2352 x 1568 pixels. Retinal fundus photograph
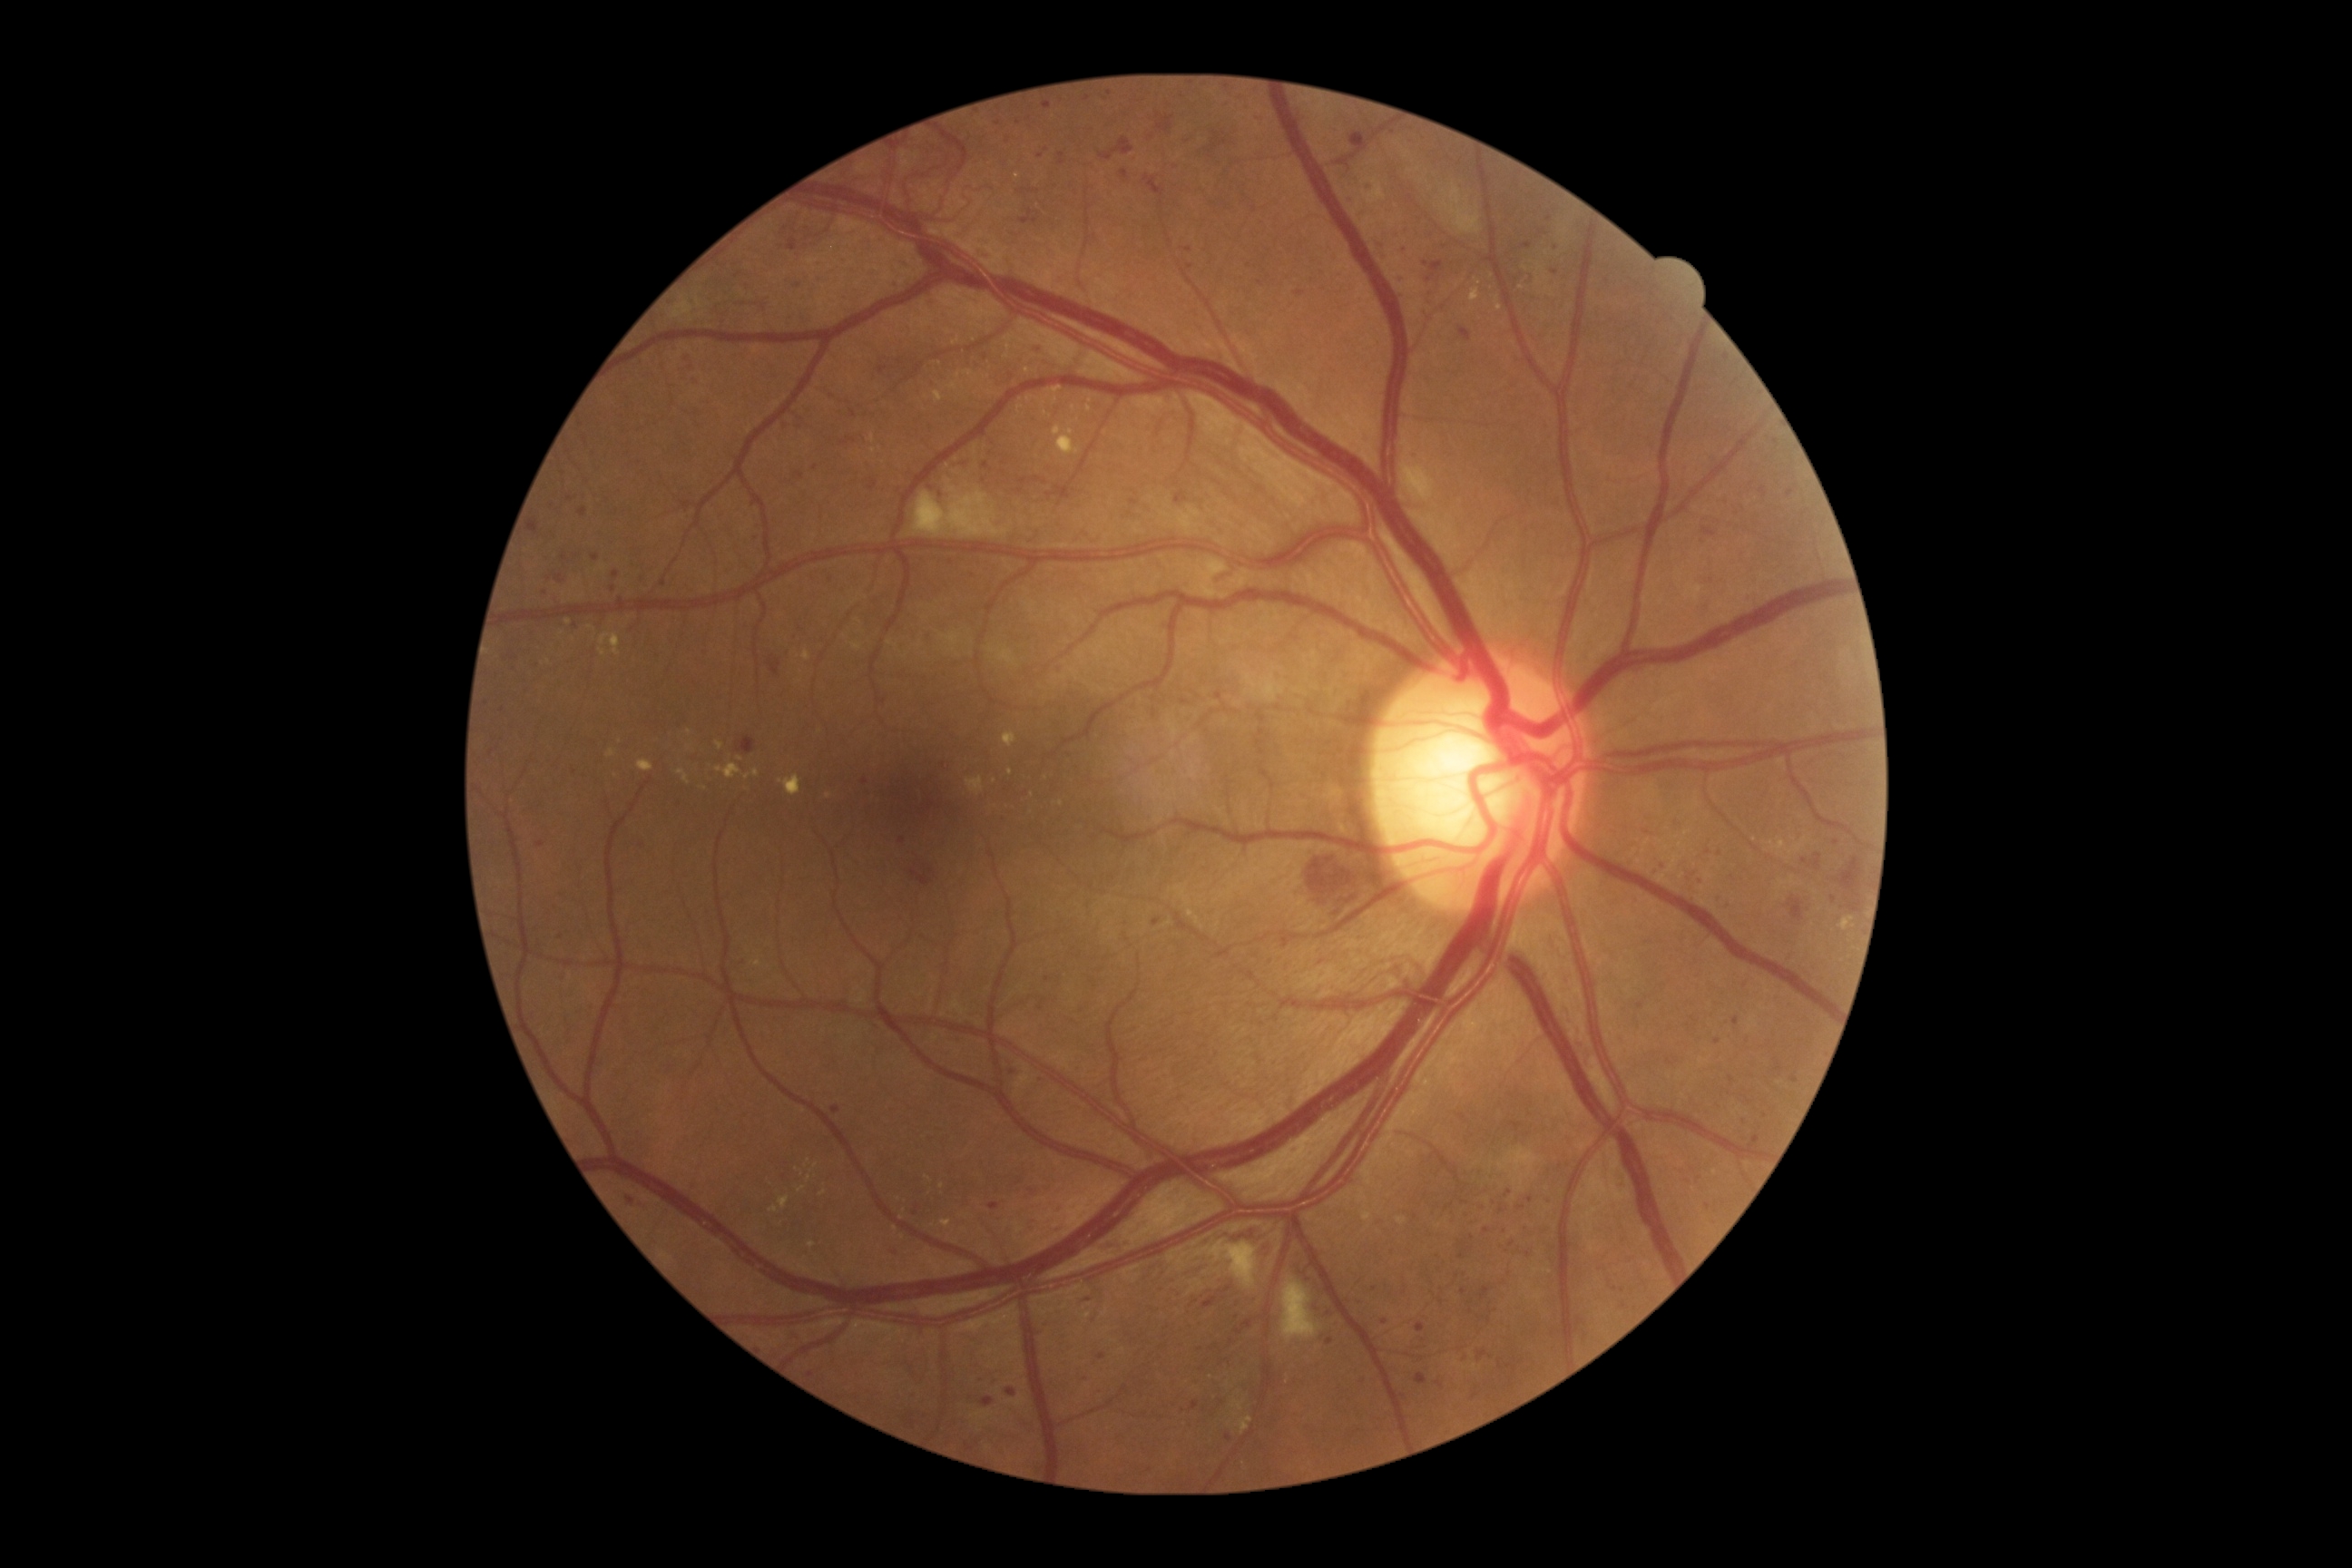

Diabetic retinopathy is grade 3; non-proliferative diabetic retinopathy
Representative lesions:
hemorrhages (partial) = 1848, 903, 1859, 912; 1202, 1297, 1217, 1309; 1099, 137, 1133, 161; 1157, 113, 1173, 135; 1028, 190, 1039, 193; 1787, 897, 1805, 923; 1703, 527, 1716, 538; 1050, 484, 1068, 500; 1032, 478, 1048, 485; 1841, 858, 1861, 890; 1095, 1237, 1133, 1250; 678, 371, 685, 386
Smaller hemorrhages around [1024, 481]; [1805, 862]
hard exudates (partial) = 1003, 732, 1017, 747; 941, 1220, 952, 1228; 1496, 304, 1504, 311; 1774, 841, 1787, 850; 1469, 288, 1480, 304; 600, 632, 622, 656; 716, 741, 725, 750
Smaller hard exudates around [1073, 408]; [1090, 402]; [808, 1179]; [1539, 283]; [568, 622]; [705, 788]; [928, 1179]; [603, 652]; [1772, 845]; [747, 777]; [1011, 773]
microaneurysms (partial) = 556, 574, 564, 585; 1792, 1075, 1799, 1083; 1021, 210, 1039, 226; 1529, 275, 1534, 284; 1723, 903, 1732, 914; 1524, 242, 1533, 250; 832, 1106, 839, 1115; 1034, 344, 1046, 355; 1436, 1382, 1444, 1387; 868, 478, 877, 491
Smaller microaneurysms around [663, 583]; [1351, 200]; [1700, 1179]; [1426, 265]; [1249, 266]; [1834, 900]; [1719, 854]; [1032, 1191]; [865, 782]; [1042, 1080]